Retinal fundus photograph:
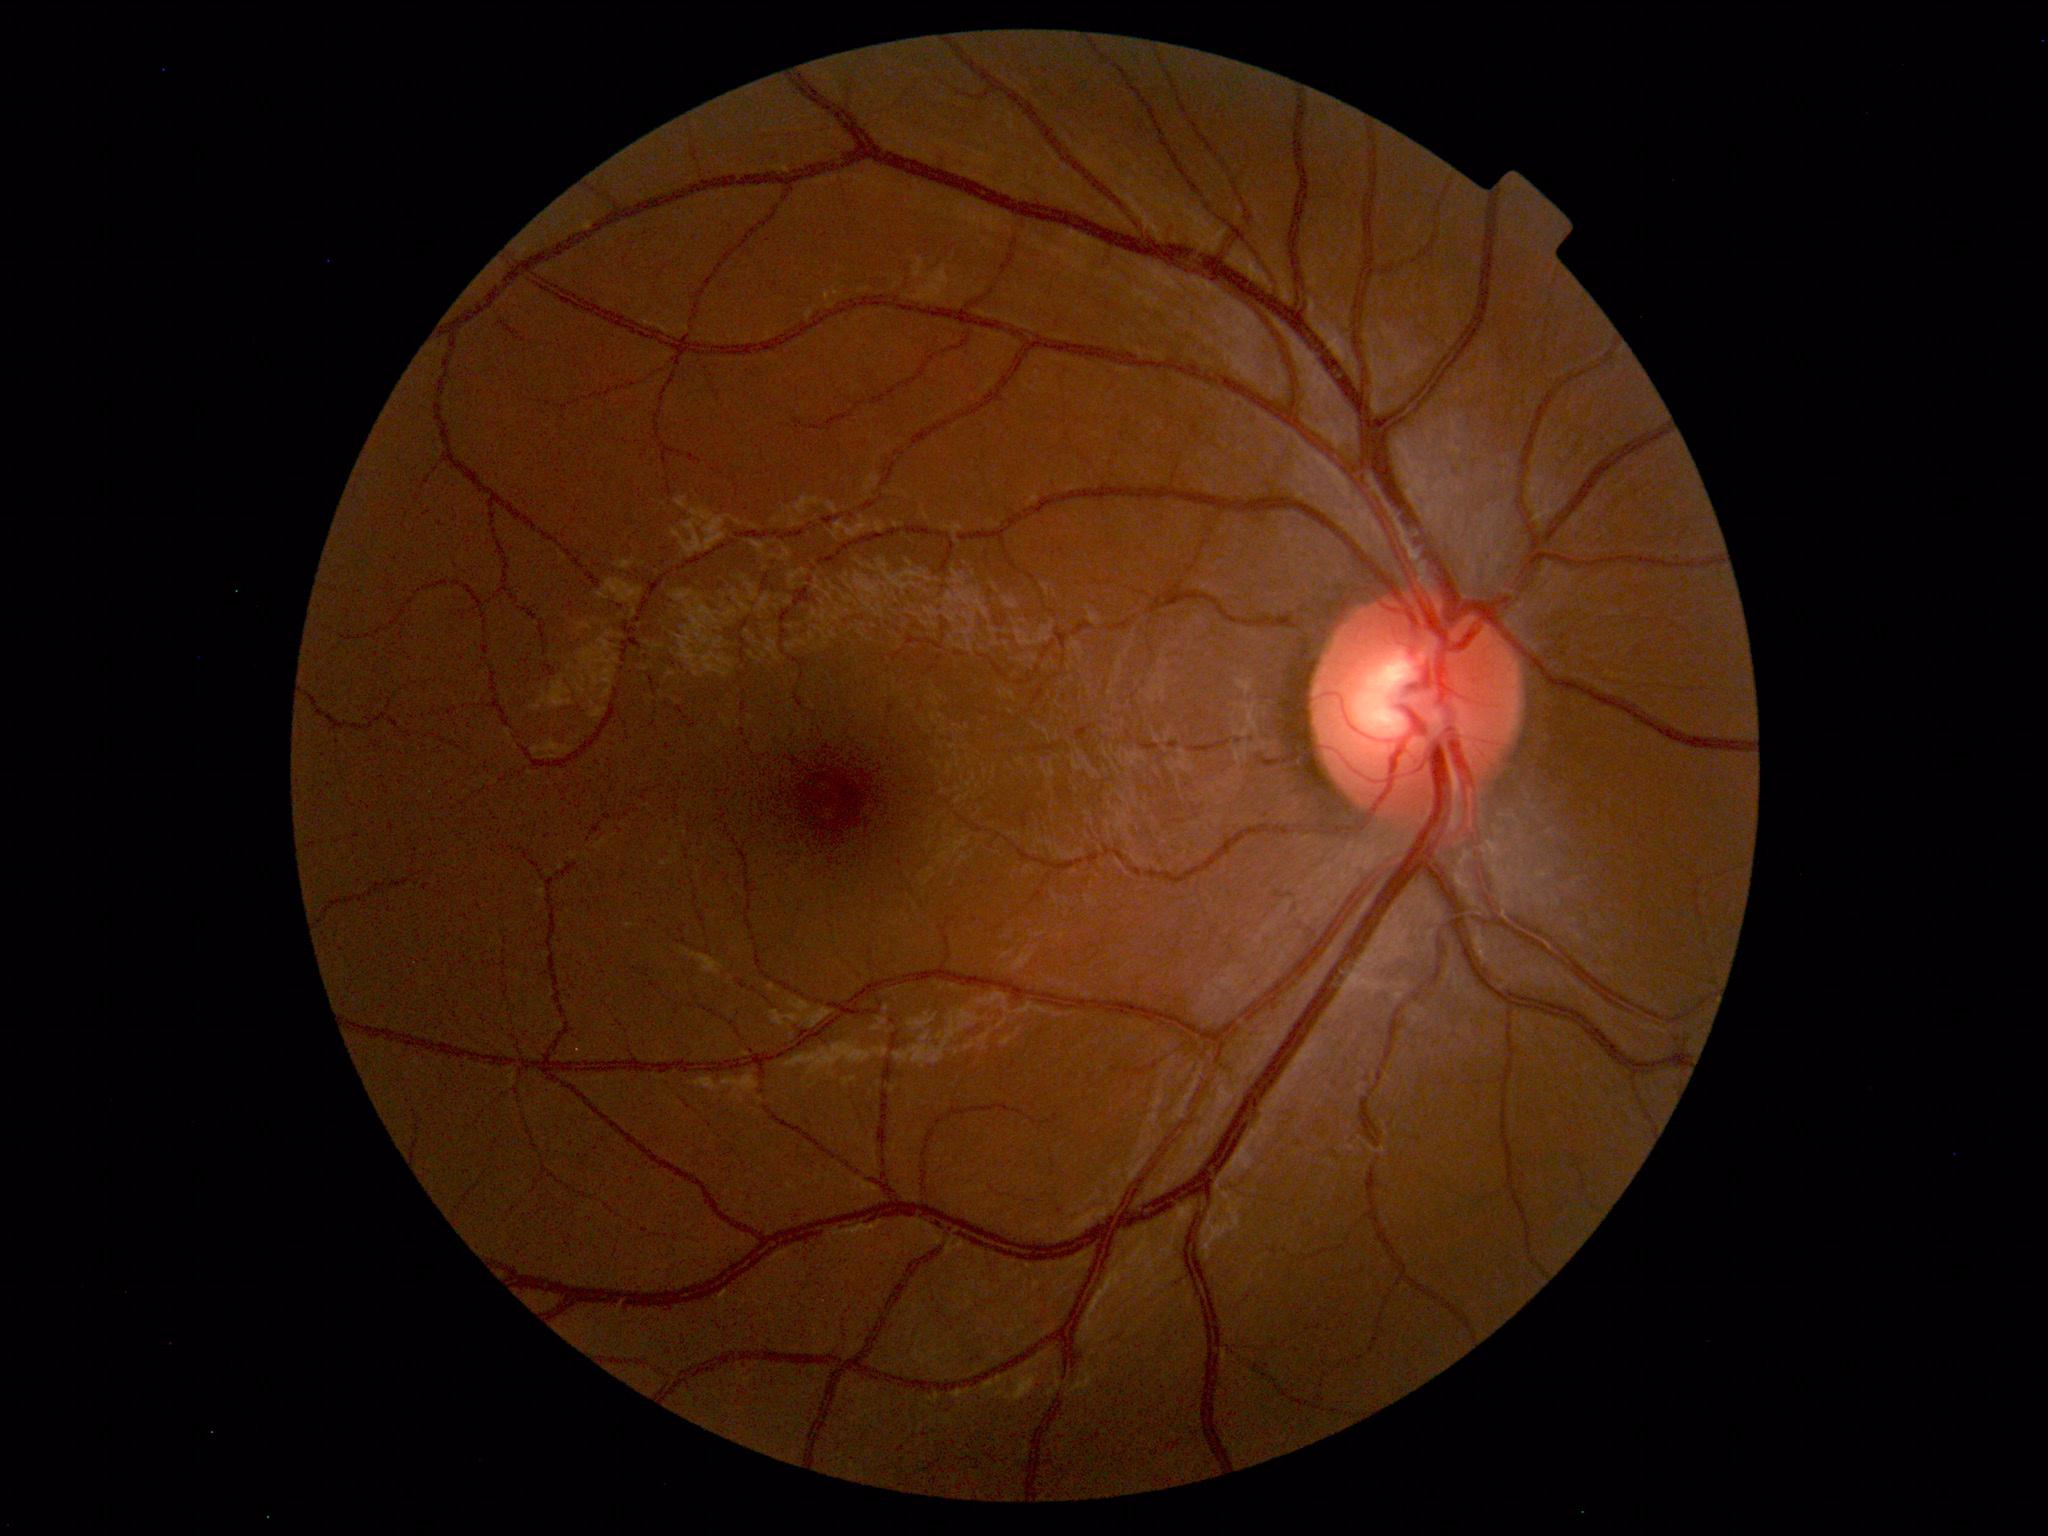 No abnormal findings on fundus examination.